Wide-field fundus photograph from neonatal ROP screening; captured with the Clarity RetCam 3 (130° field of view).
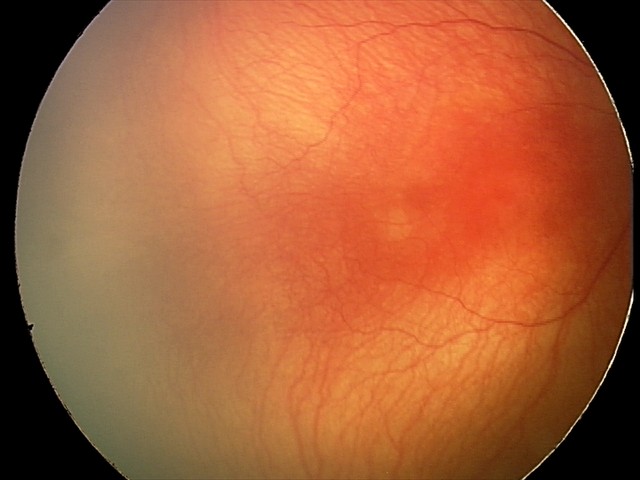 Q: What is the diagnosis from this examination?
A: aggressive retinopathy of prematurity